Phoenix ICON wide-field infant fundus image. Camera: Phoenix ICON (100° FOV):
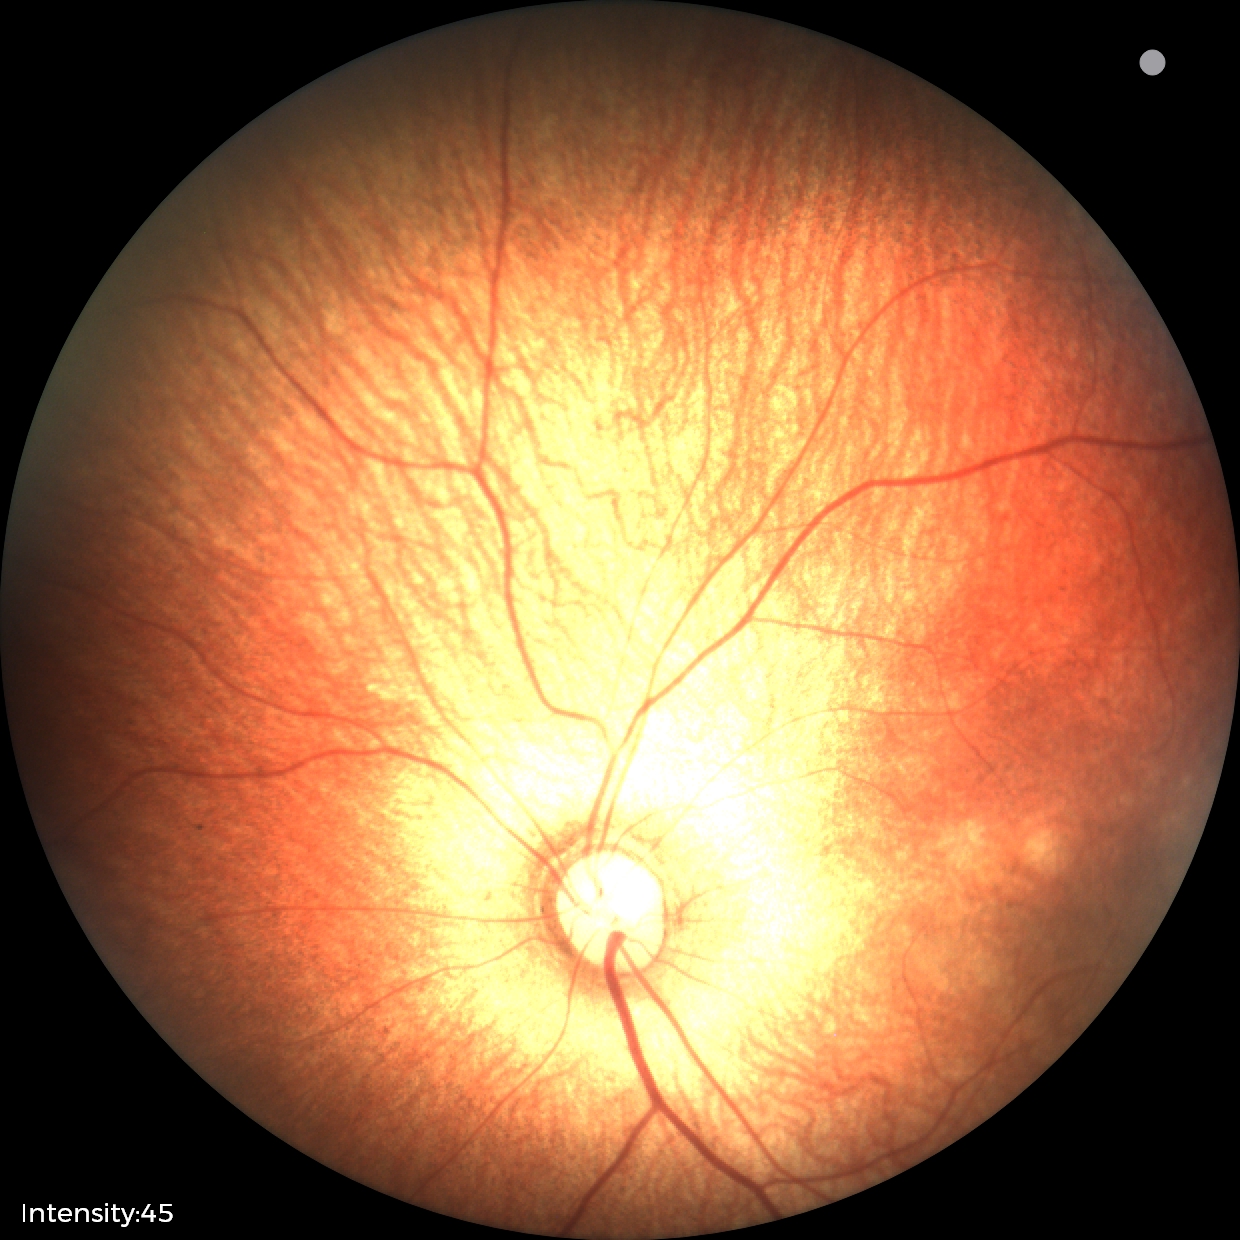

Screening examination with no abnormal retinal findings.